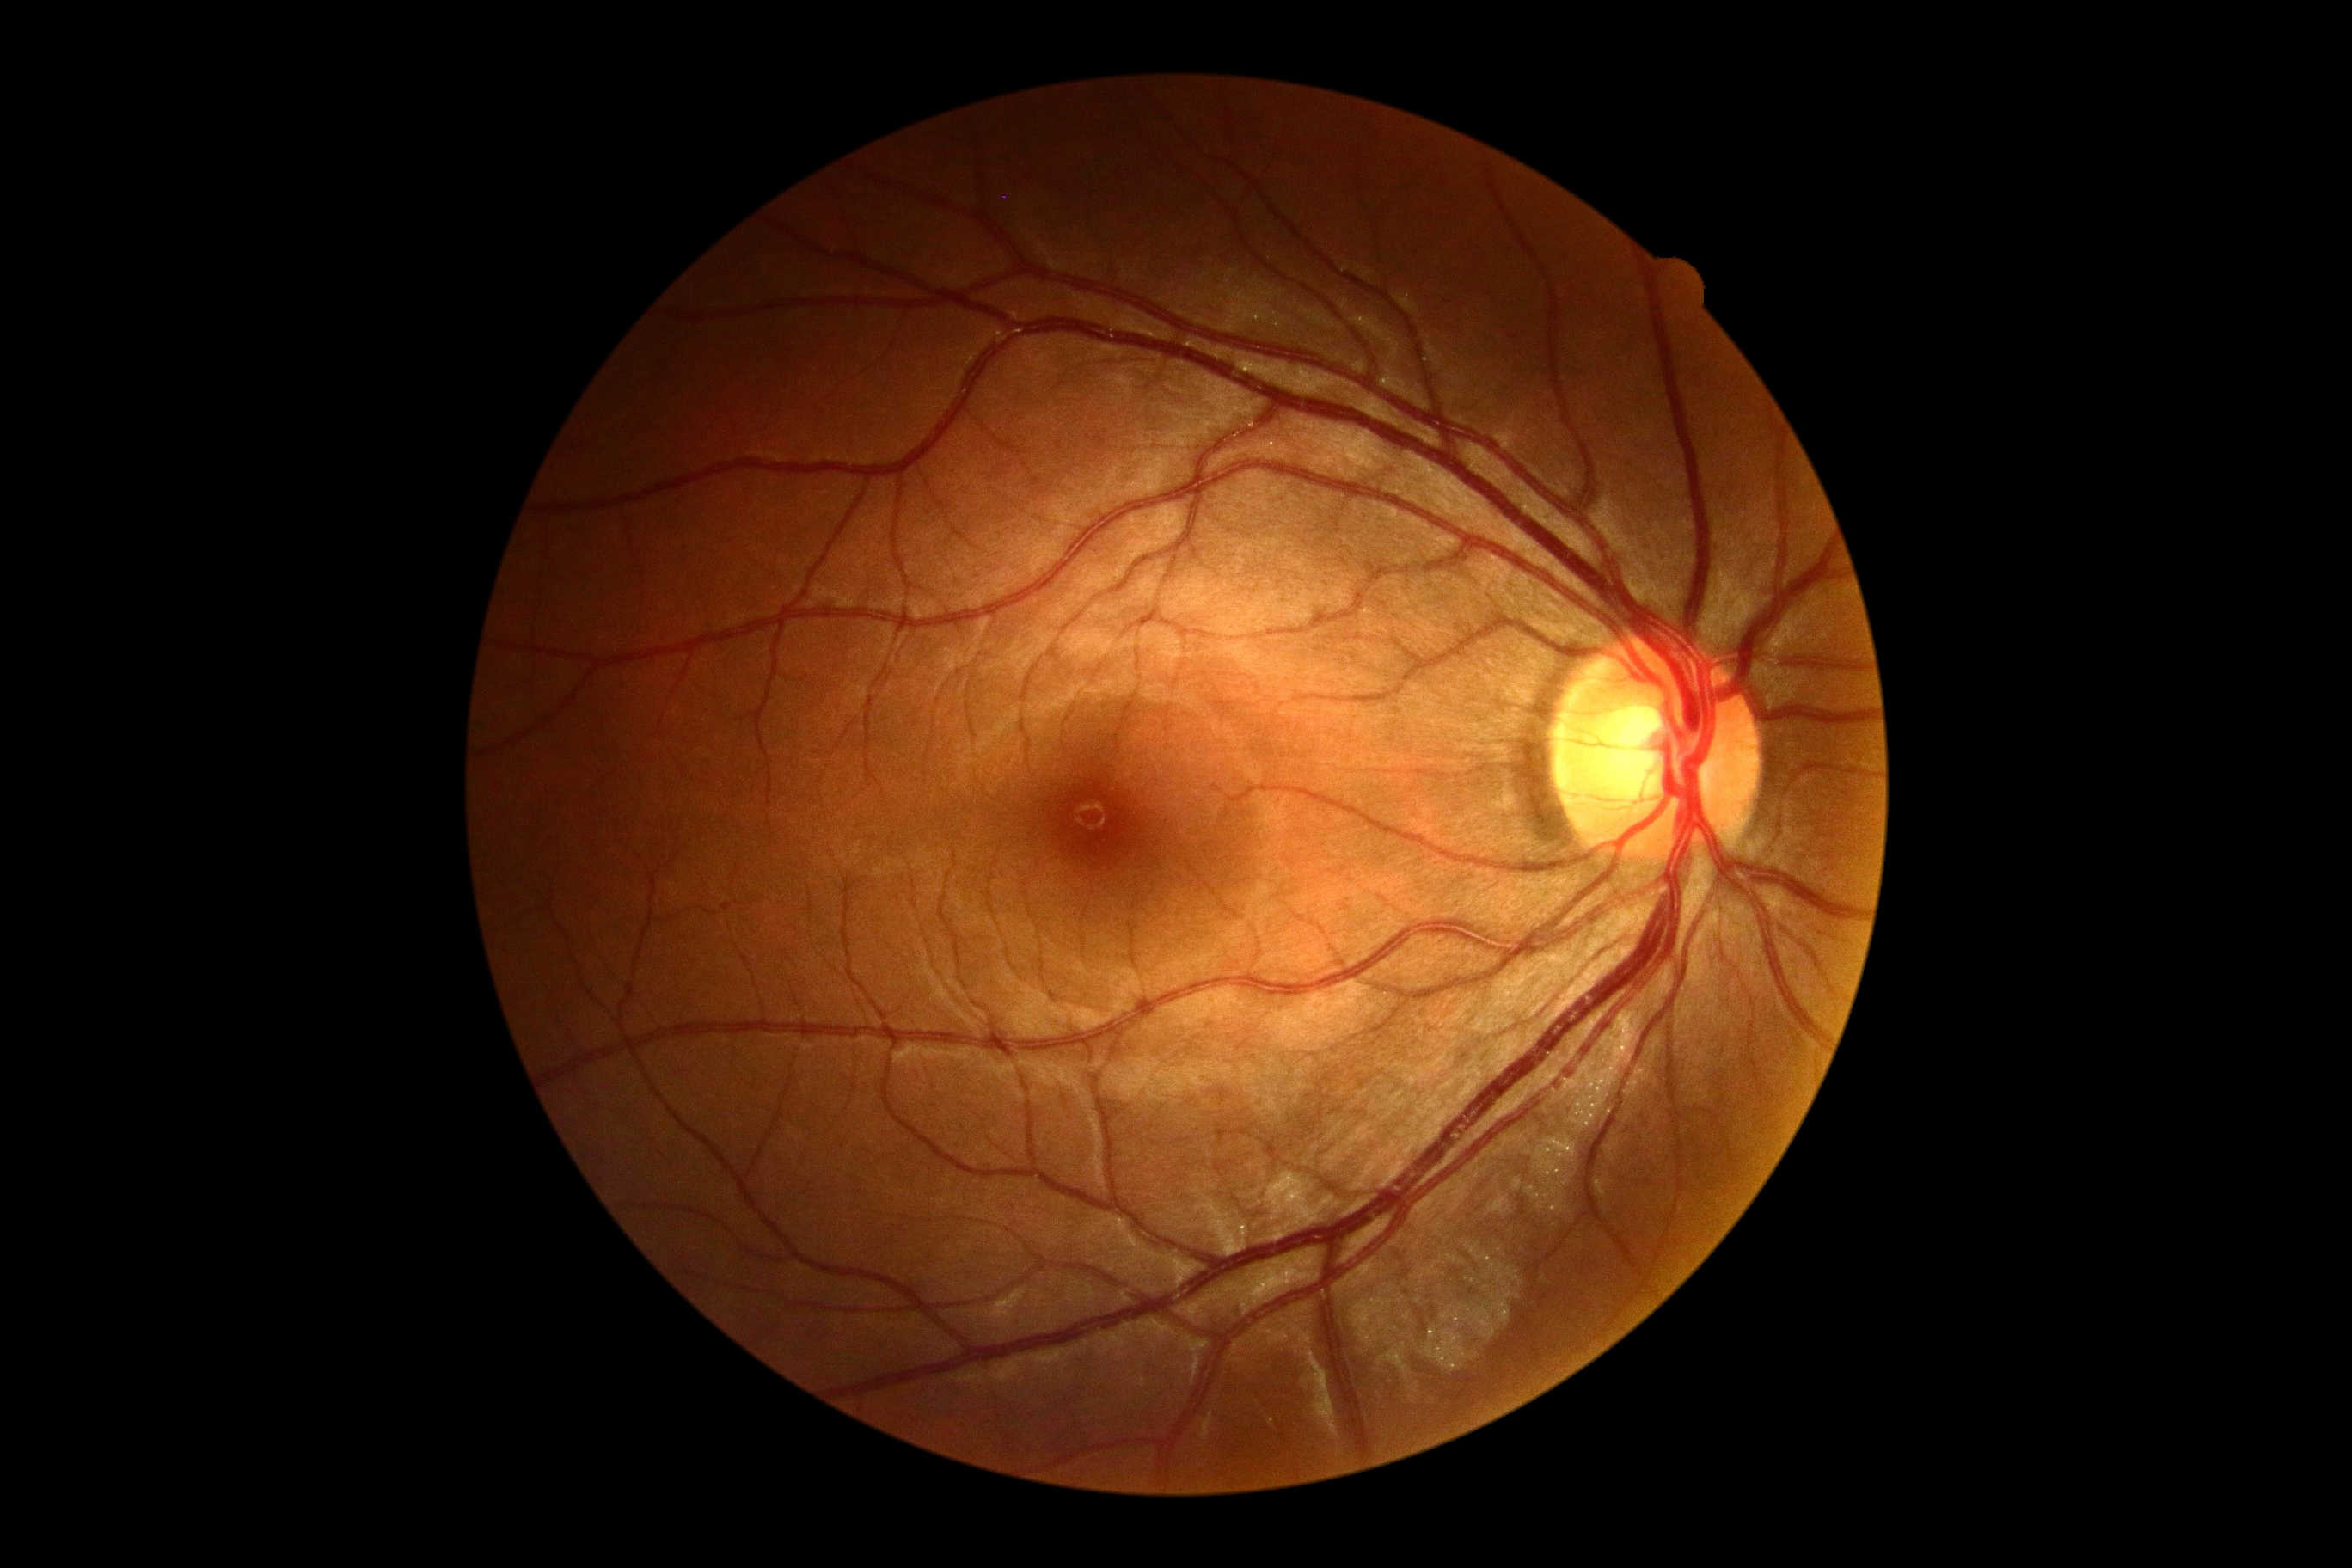
Diabetic retinopathy (DR): 0/4. No apparent diabetic retinopathy.